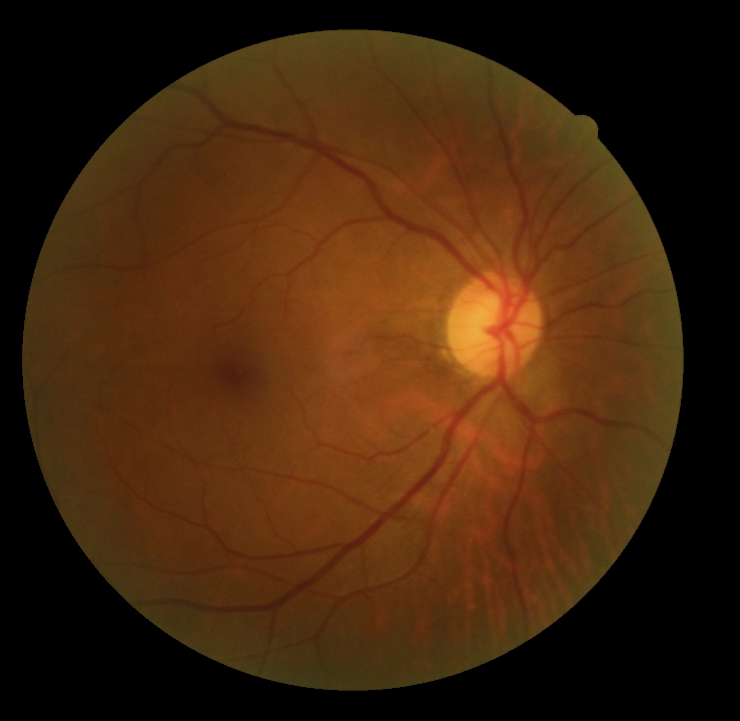

No signs of diabetic retinopathy.
DR grade: 0 (no apparent retinopathy) — no visible signs of diabetic retinopathy.